CFP · camera: NIDEK AFC-230 · modified Davis classification: 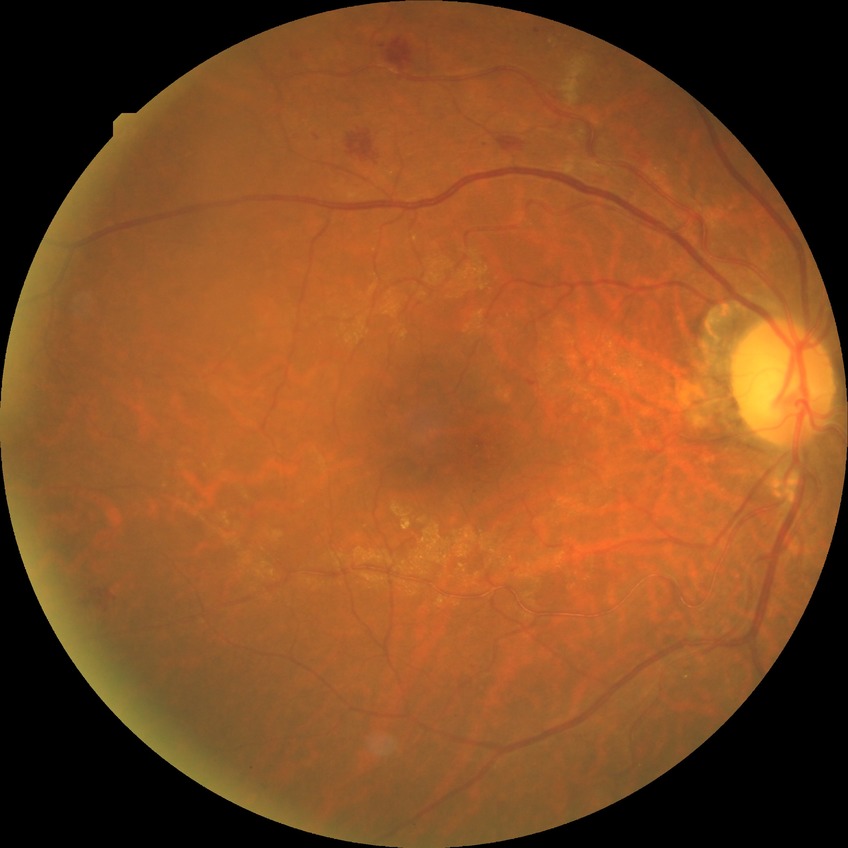
Davis grade is SDR. DR class: non-proliferative diabetic retinopathy.